45-degree field of view: 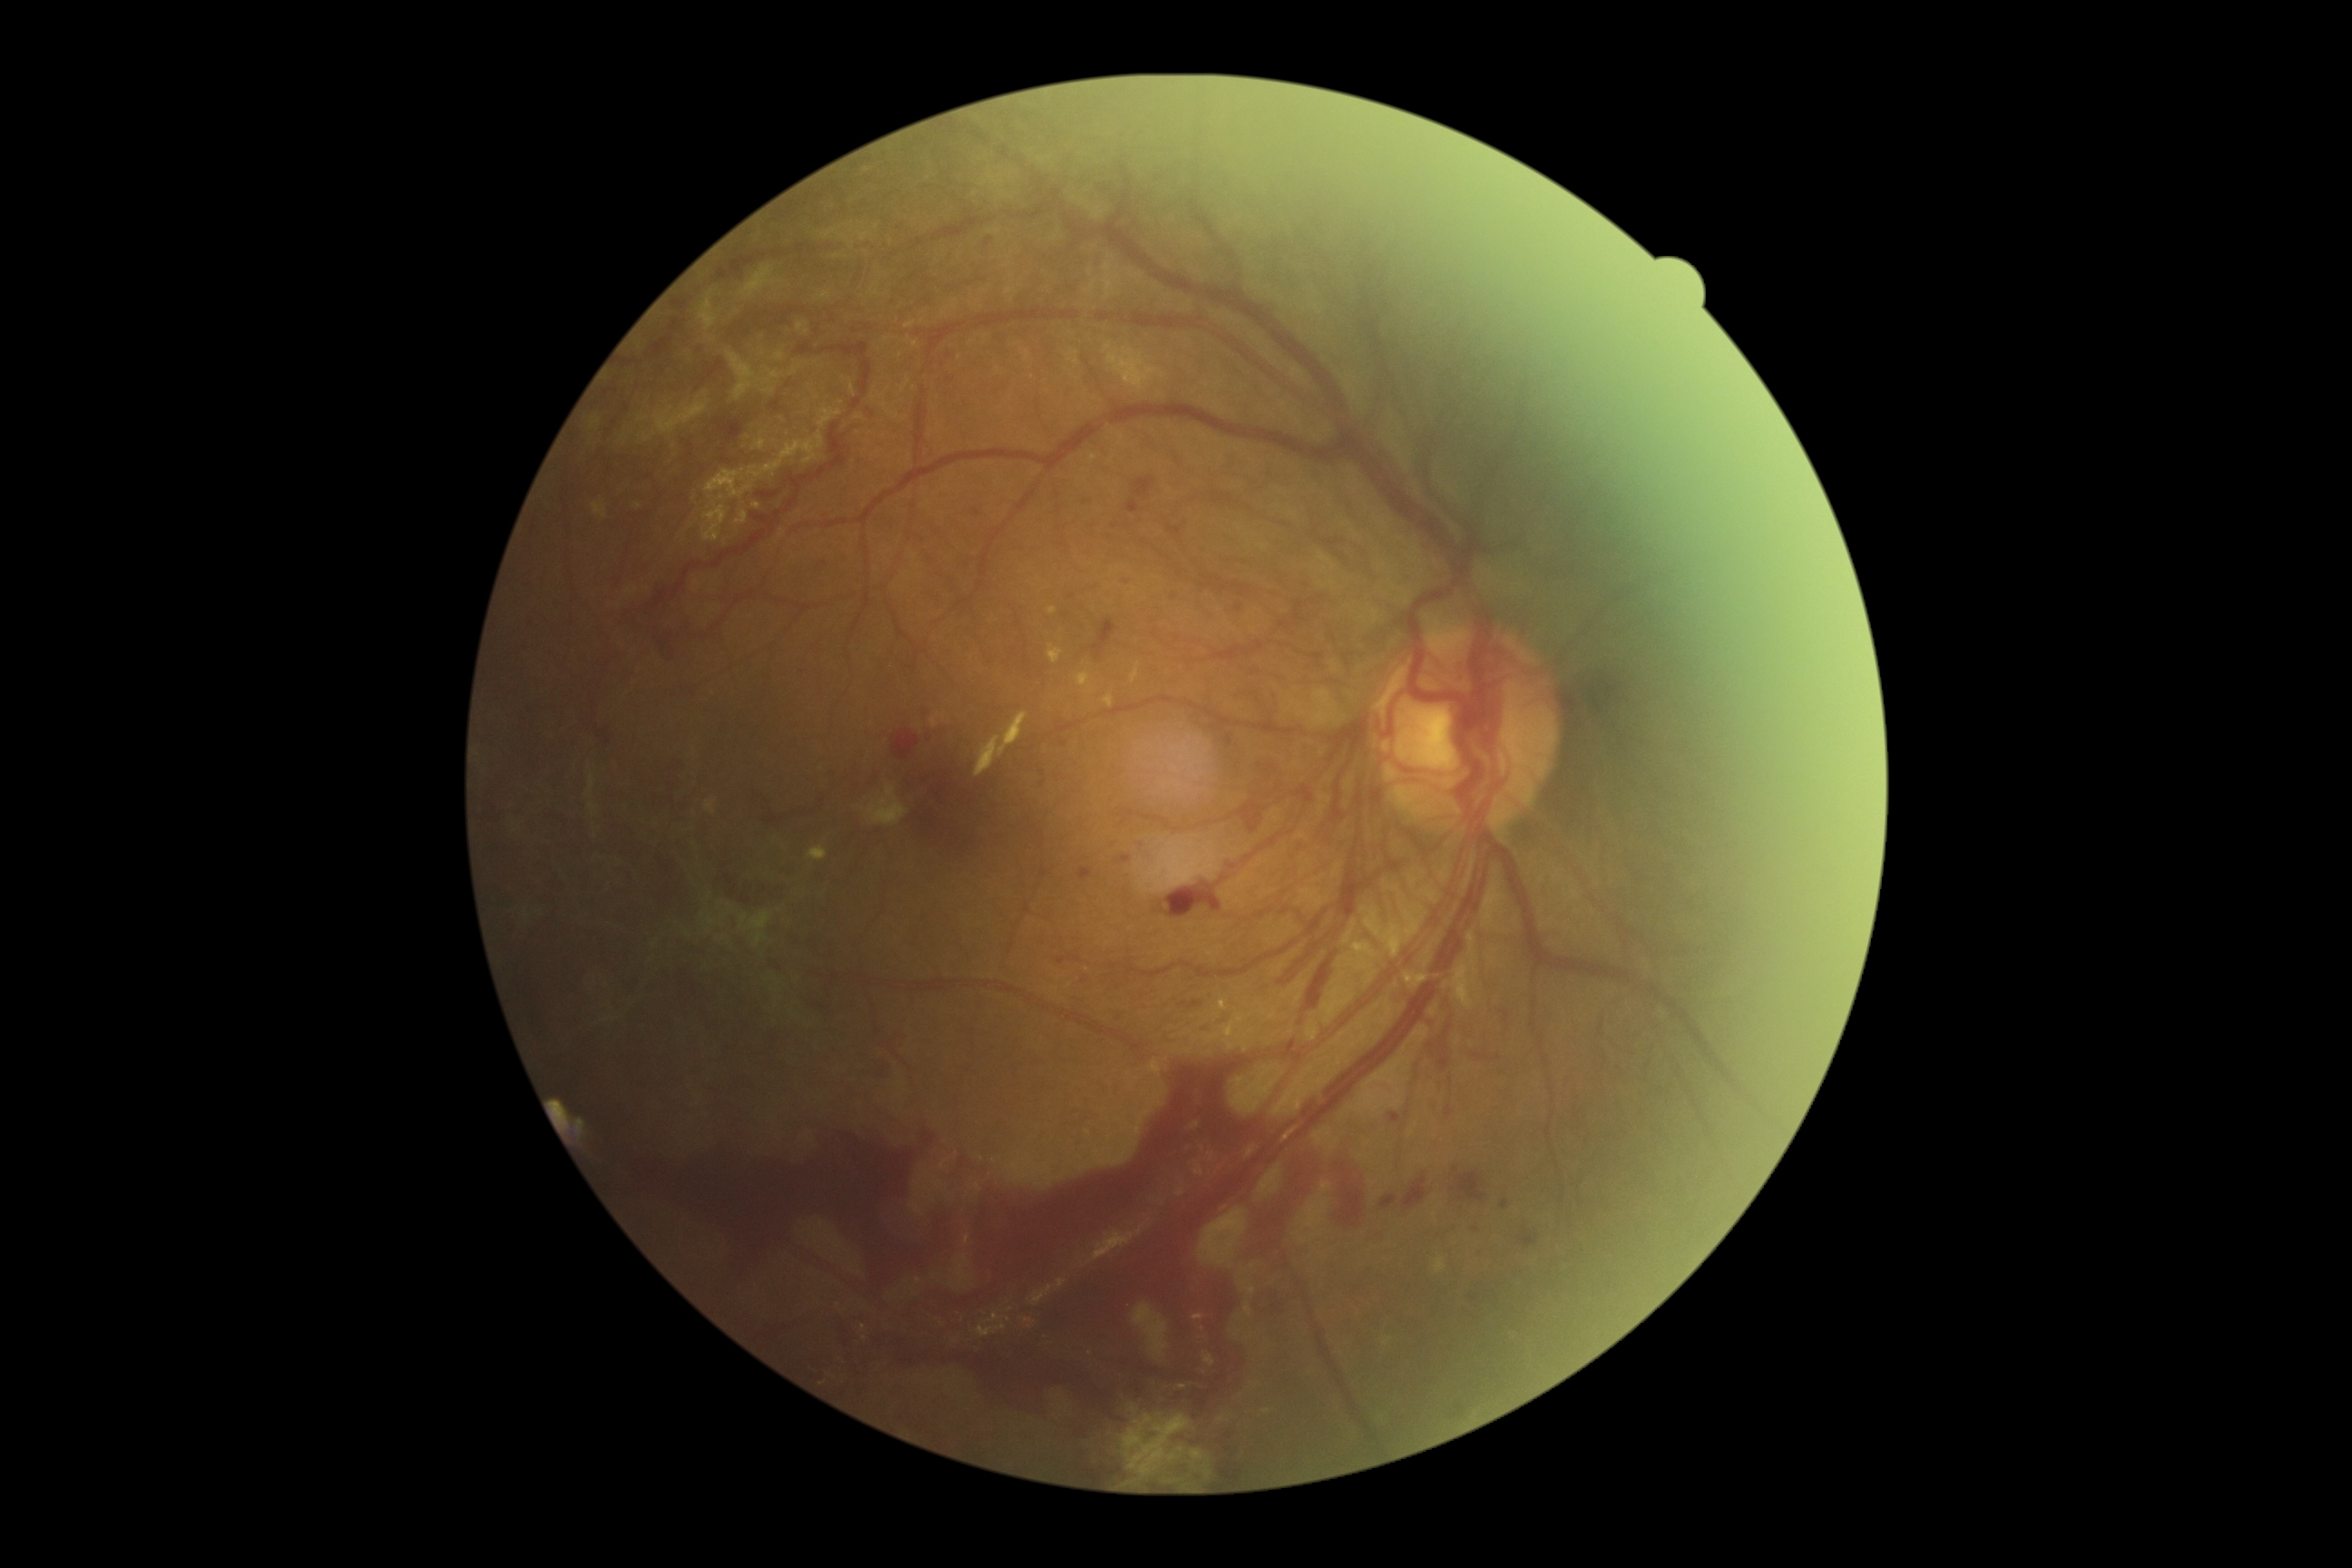 DR stage is grade 4. Disease class: proliferative diabetic retinopathy.